2352x1568; retinal fundus photograph.
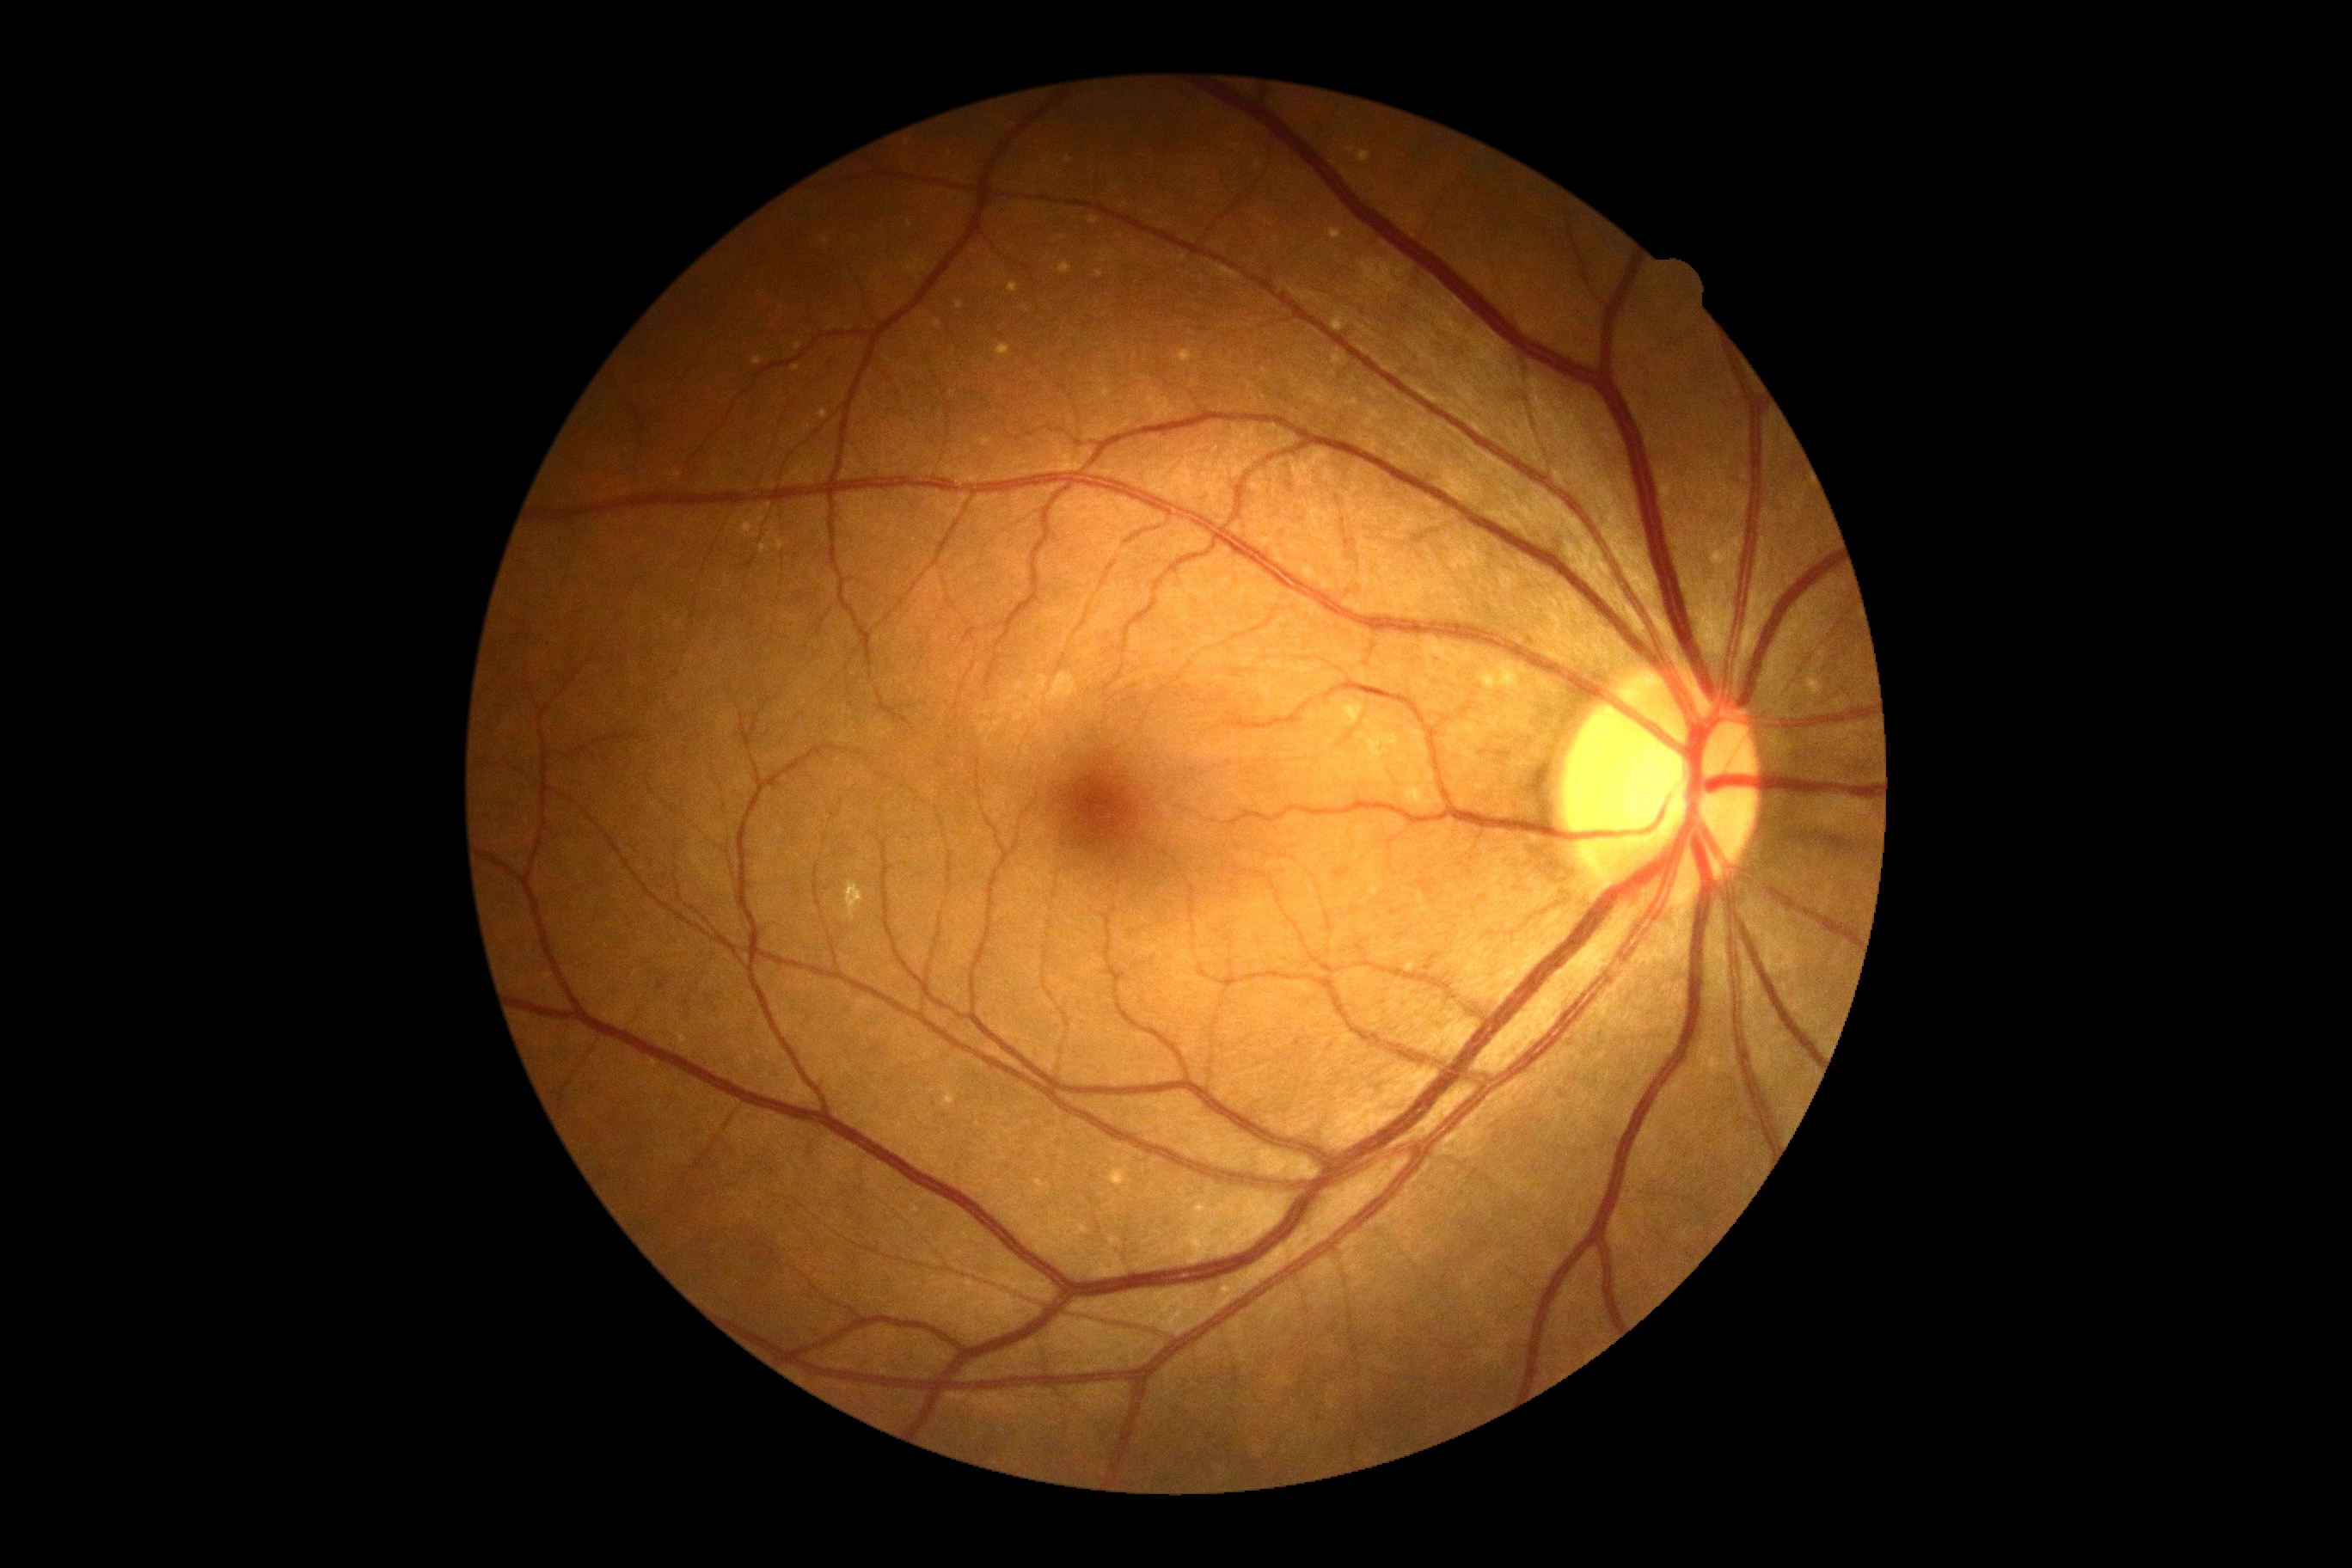
– diabetic retinopathy (DR) — no apparent retinopathy (grade 0)